Pediatric retinal photograph (wide-field); 130° field of view (Natus RetCam Envision): 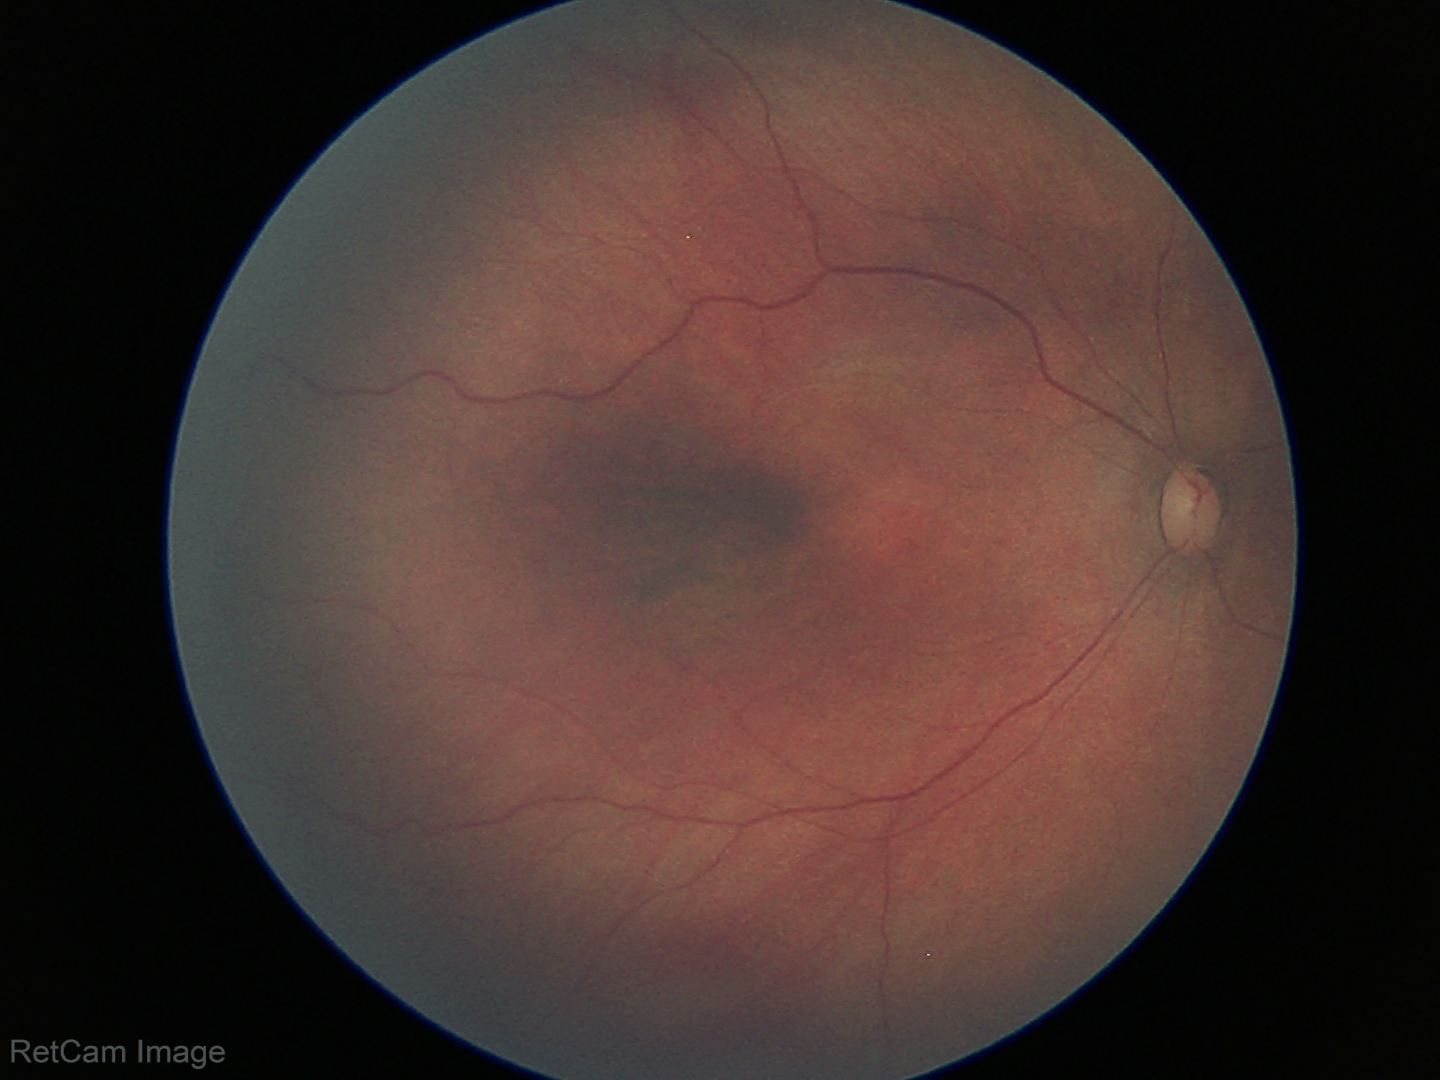

Assessment: no pathology identified.